Nonmydriatic: 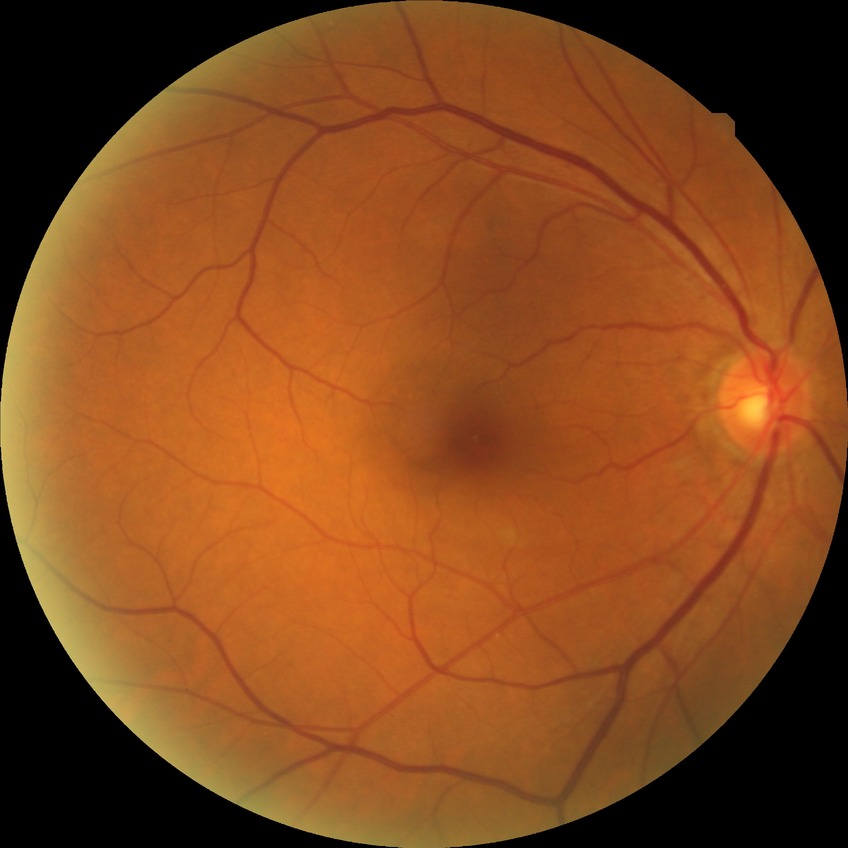 • diabetic retinopathy (DR): NDR (no diabetic retinopathy)